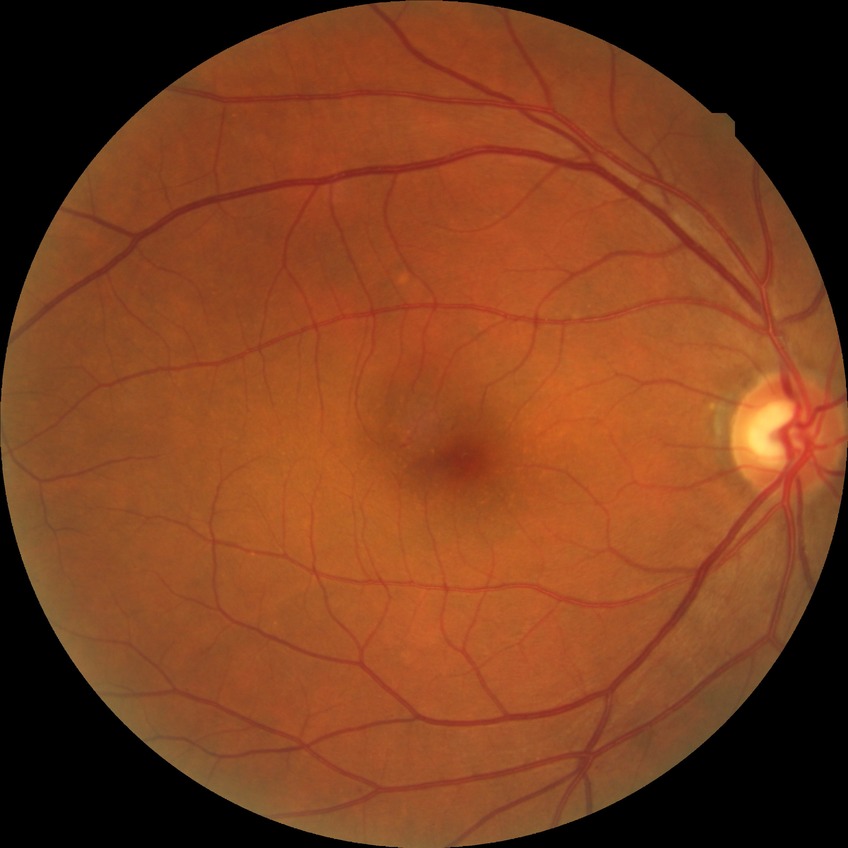
Diabetic retinopathy (DR) is no diabetic retinopathy (NDR).